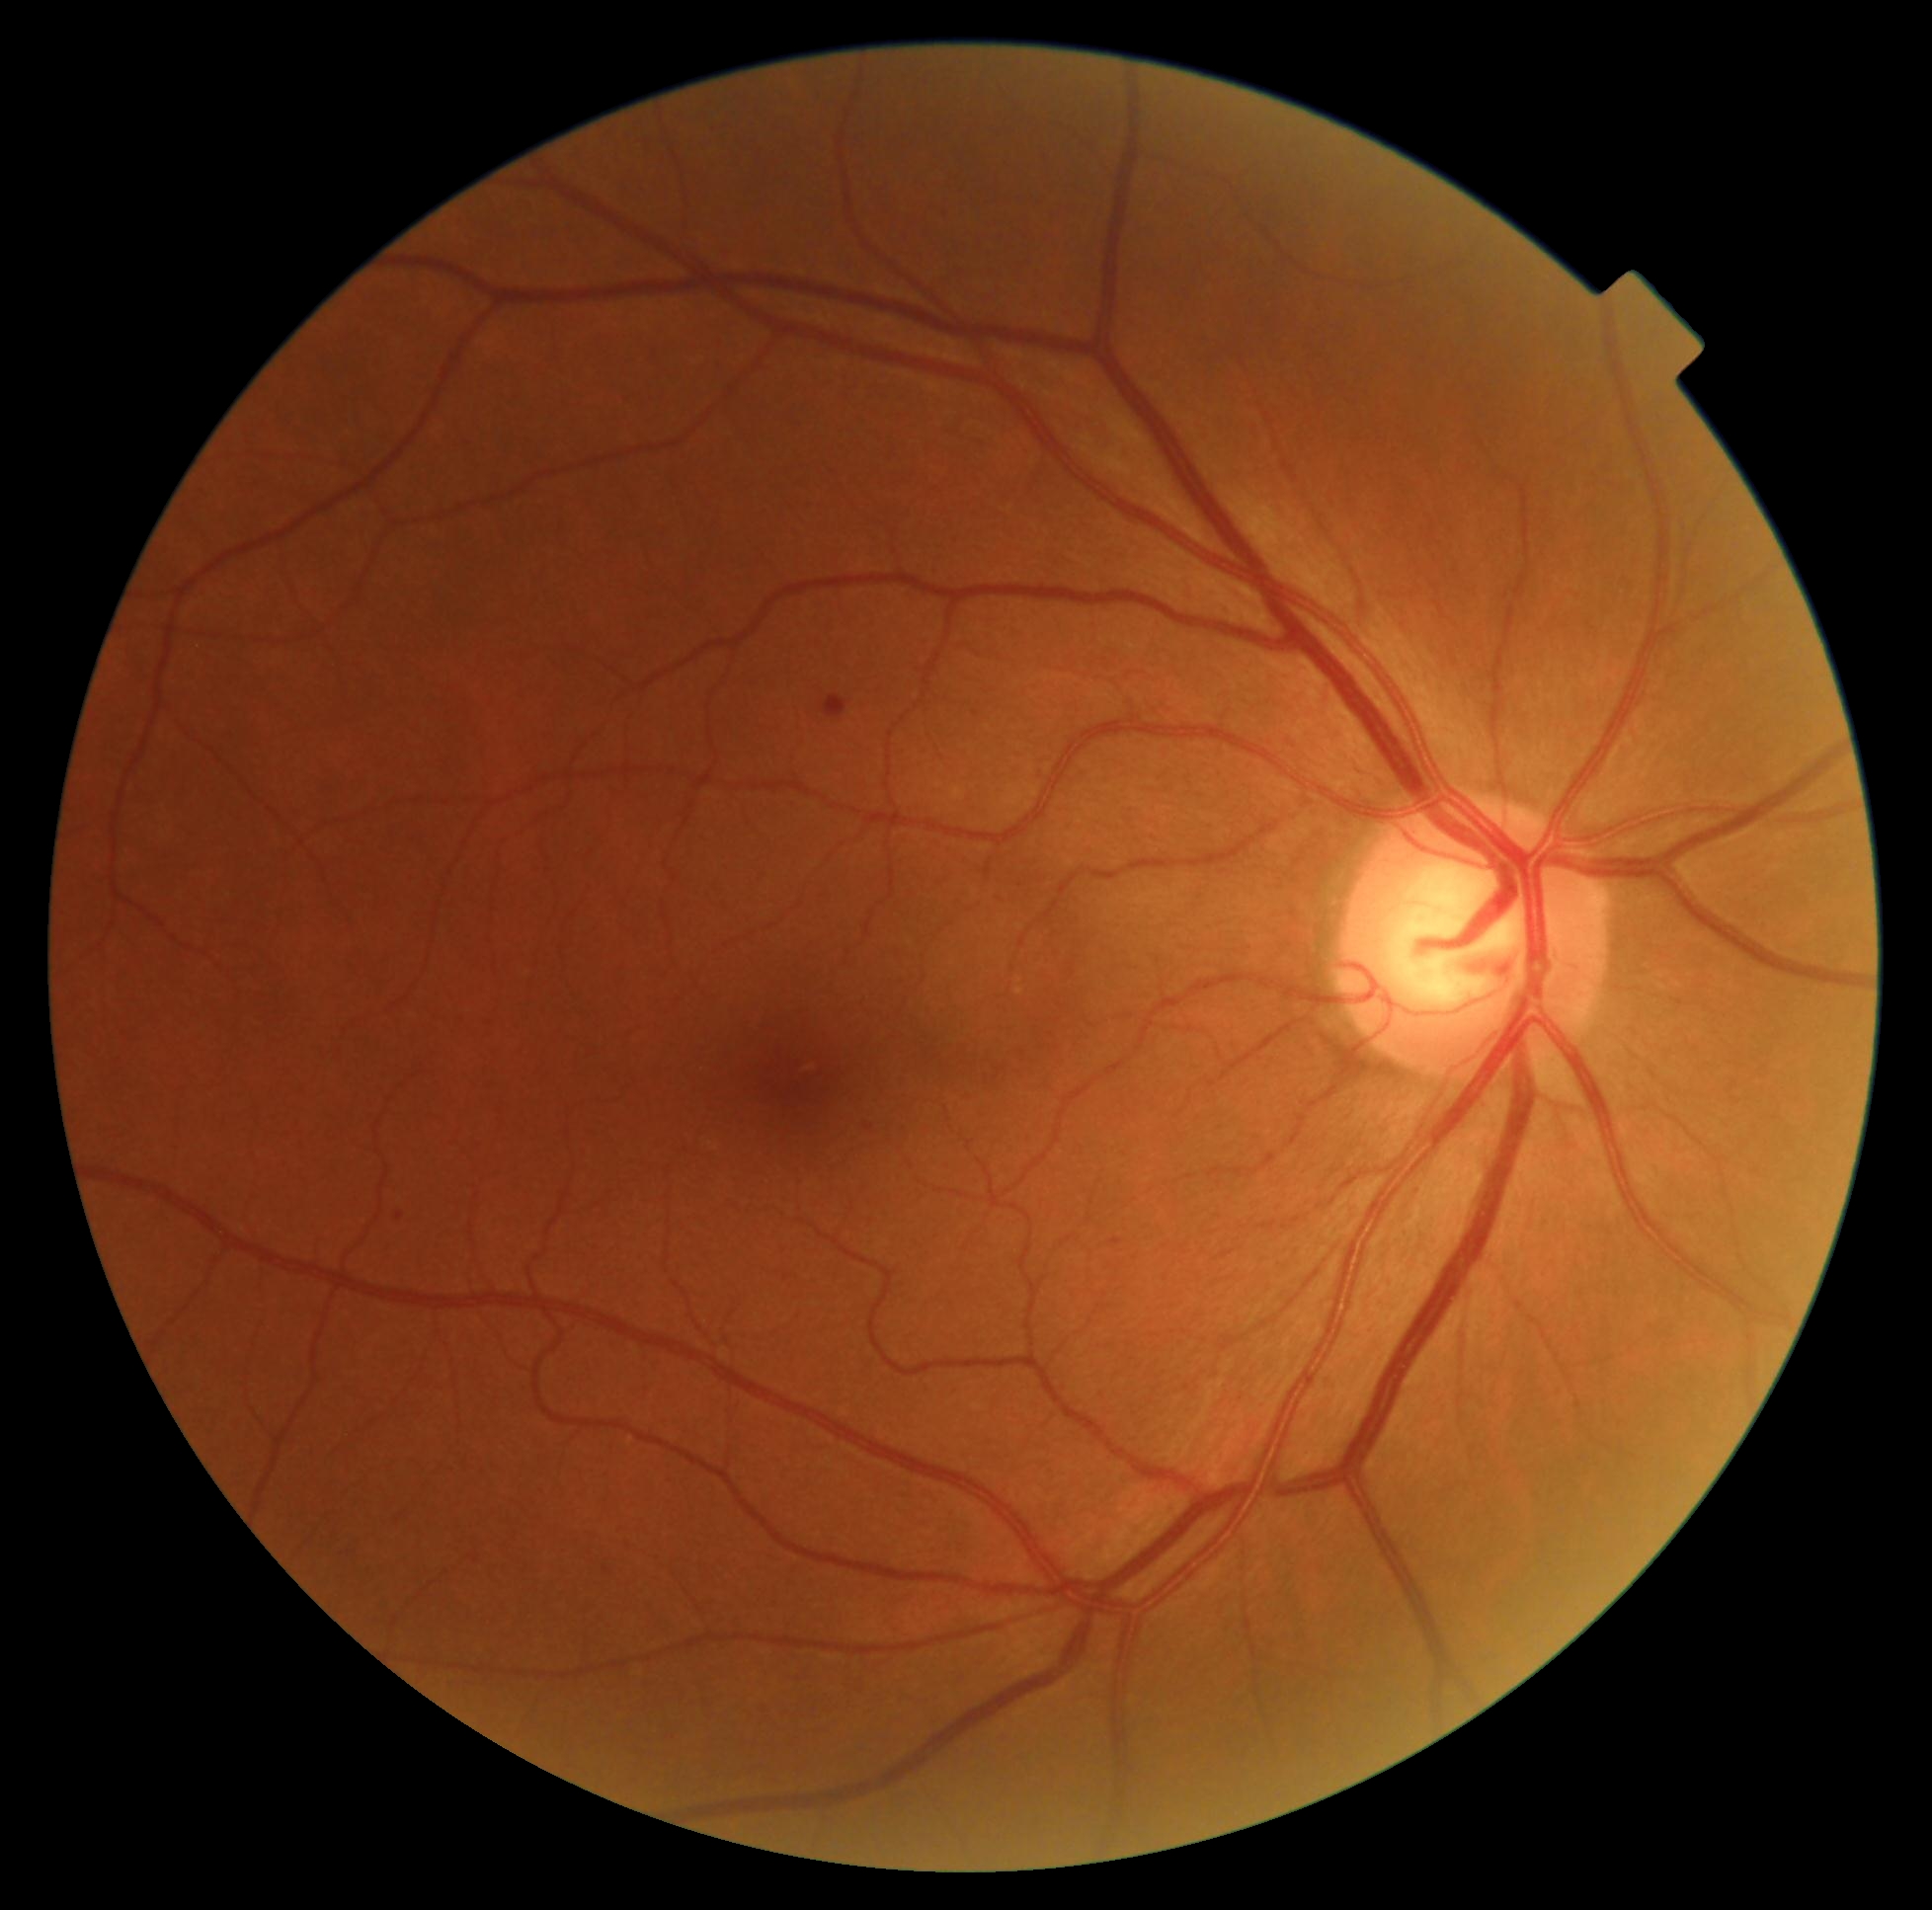 retinopathy: grade 2 (moderate NPDR).